Without pupil dilation. NIDEK AFC-230 fundus camera:
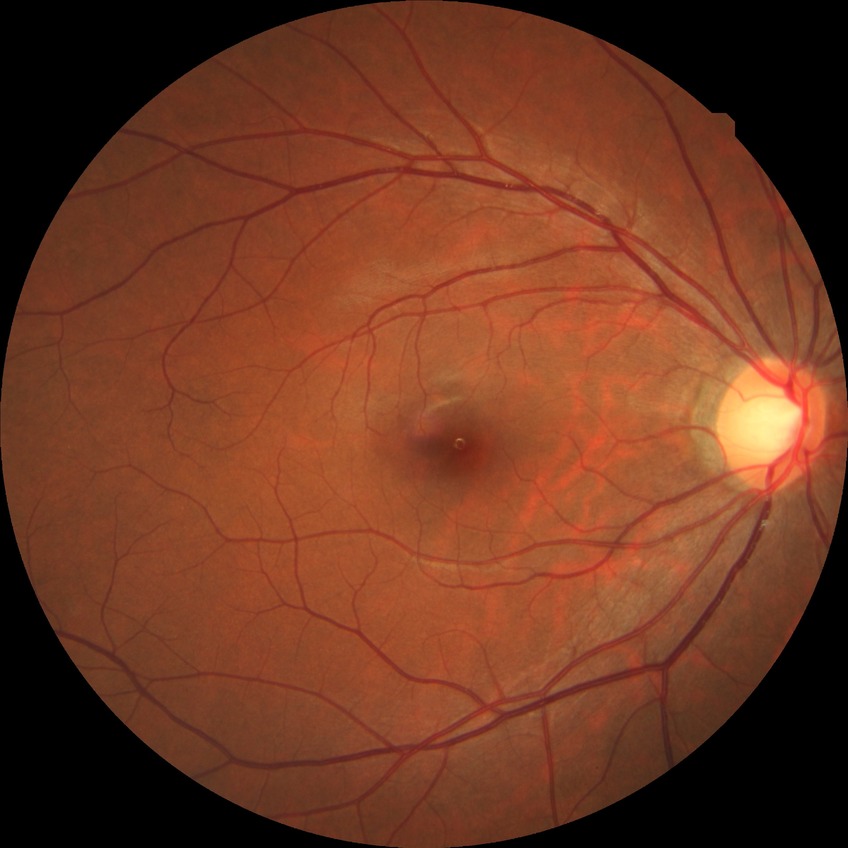 Diabetic retinopathy (DR) is NDR (no diabetic retinopathy).